45° field of view · CFP: 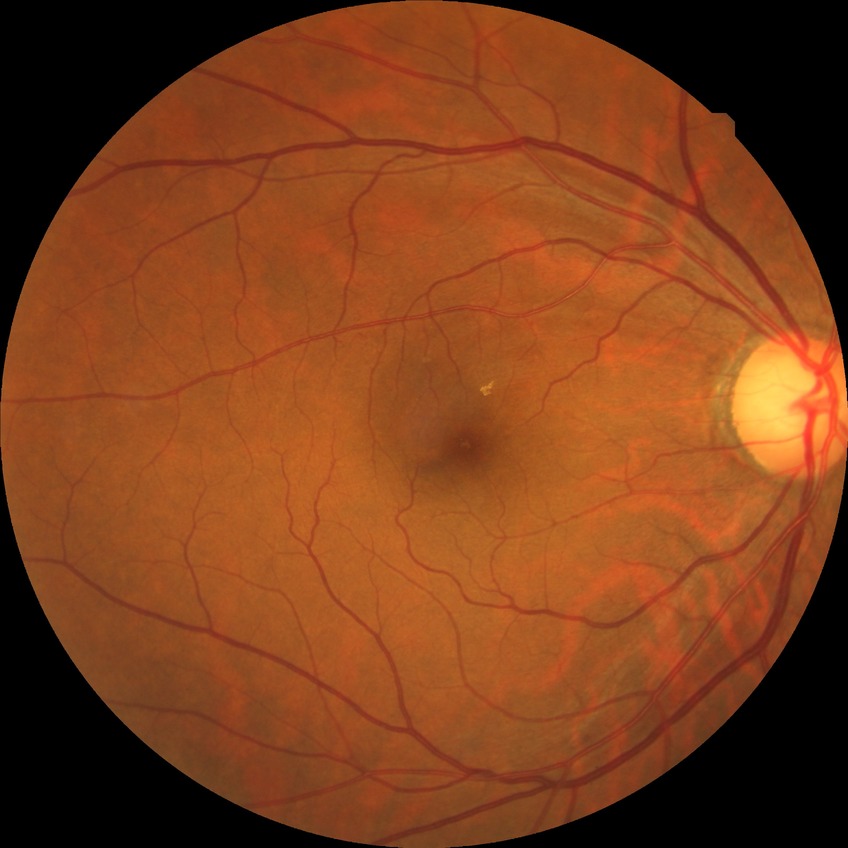
{
  "davis_grade": "NDR (no diabetic retinopathy)"
}